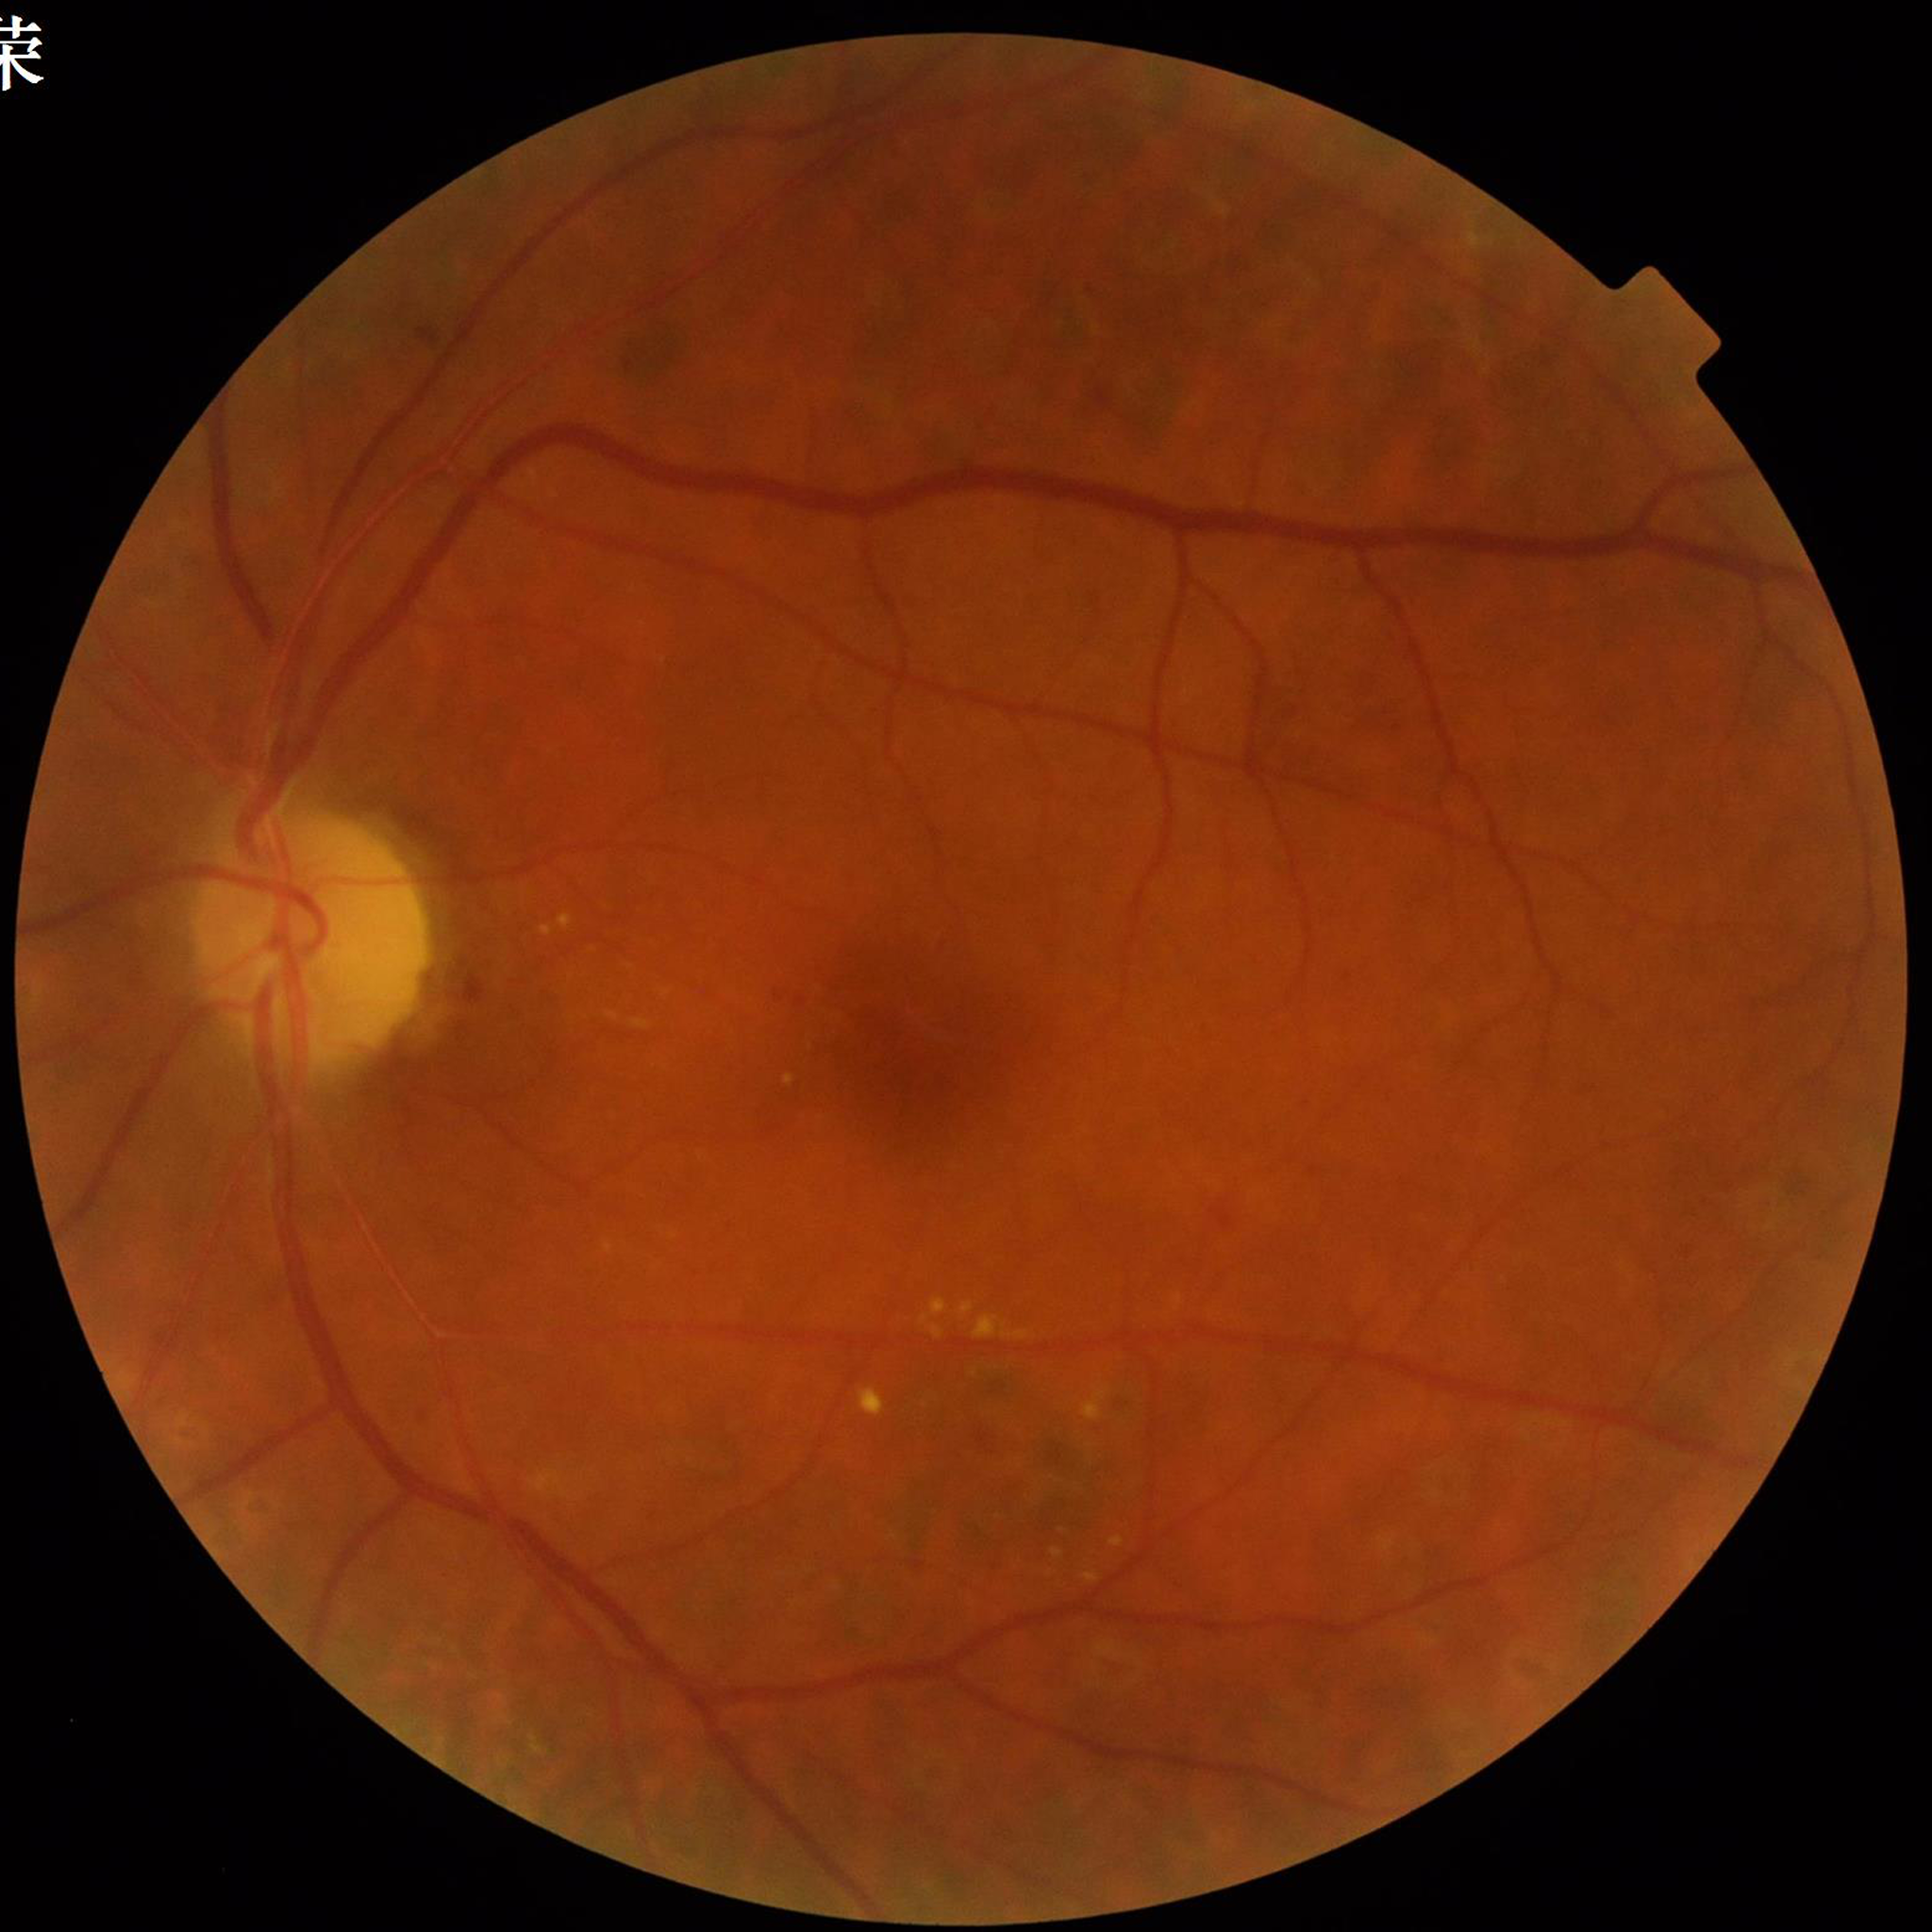 Color fundus photo. Patient diagnosed with diabetic retinopathy.